Fundus photo — 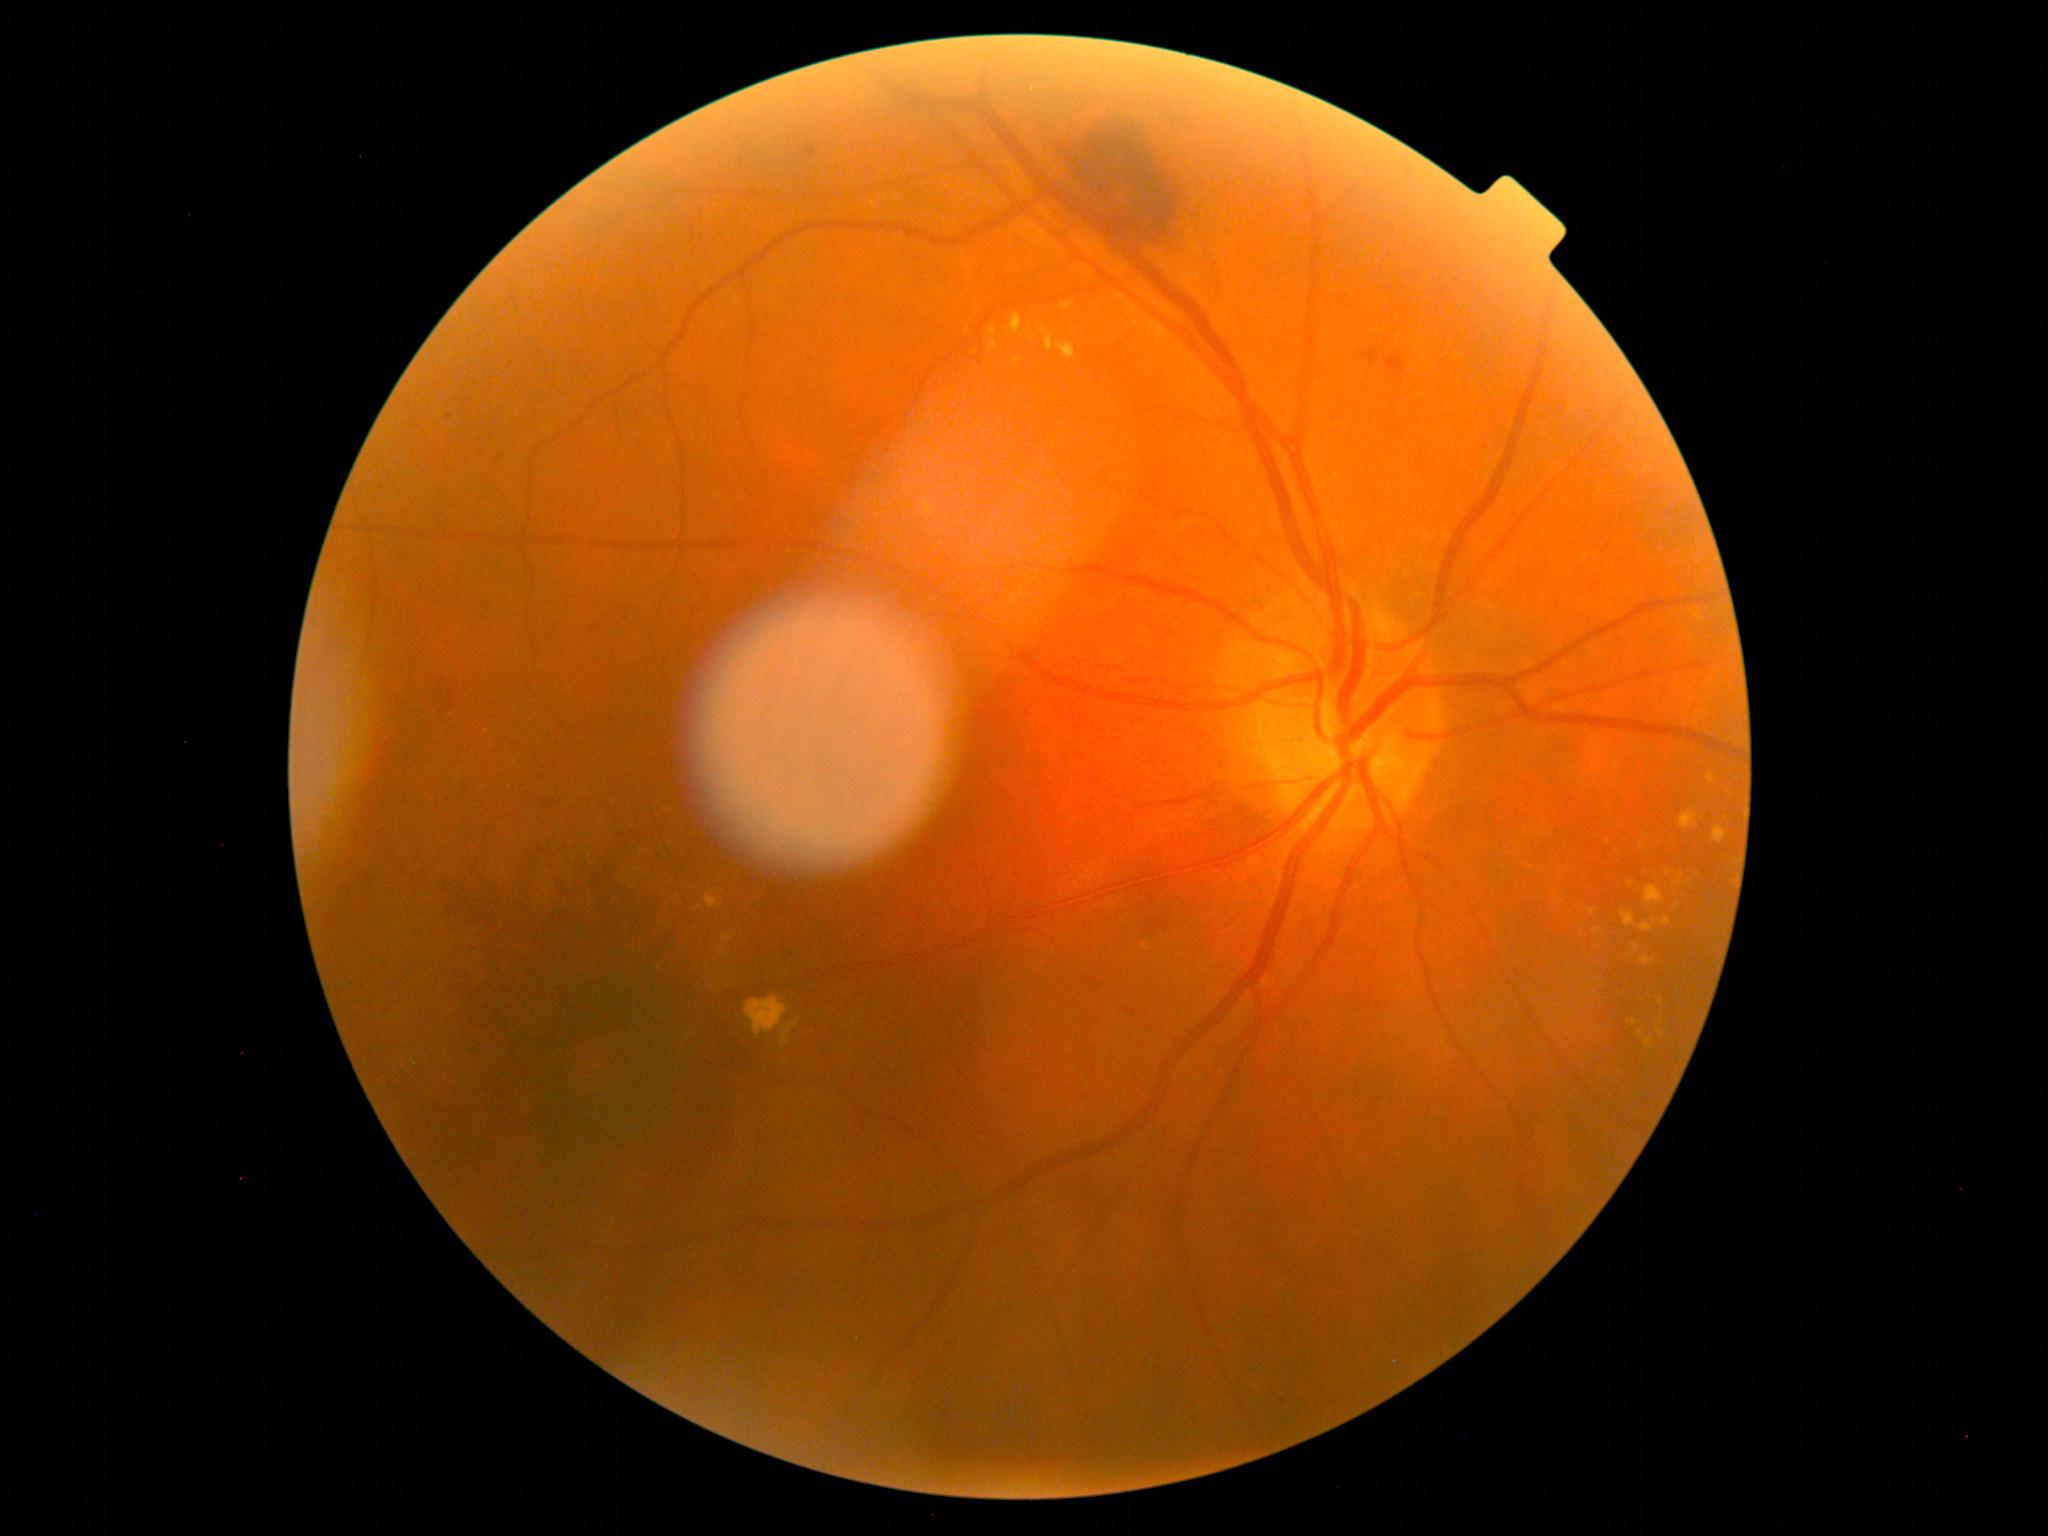 DR: grade 2.